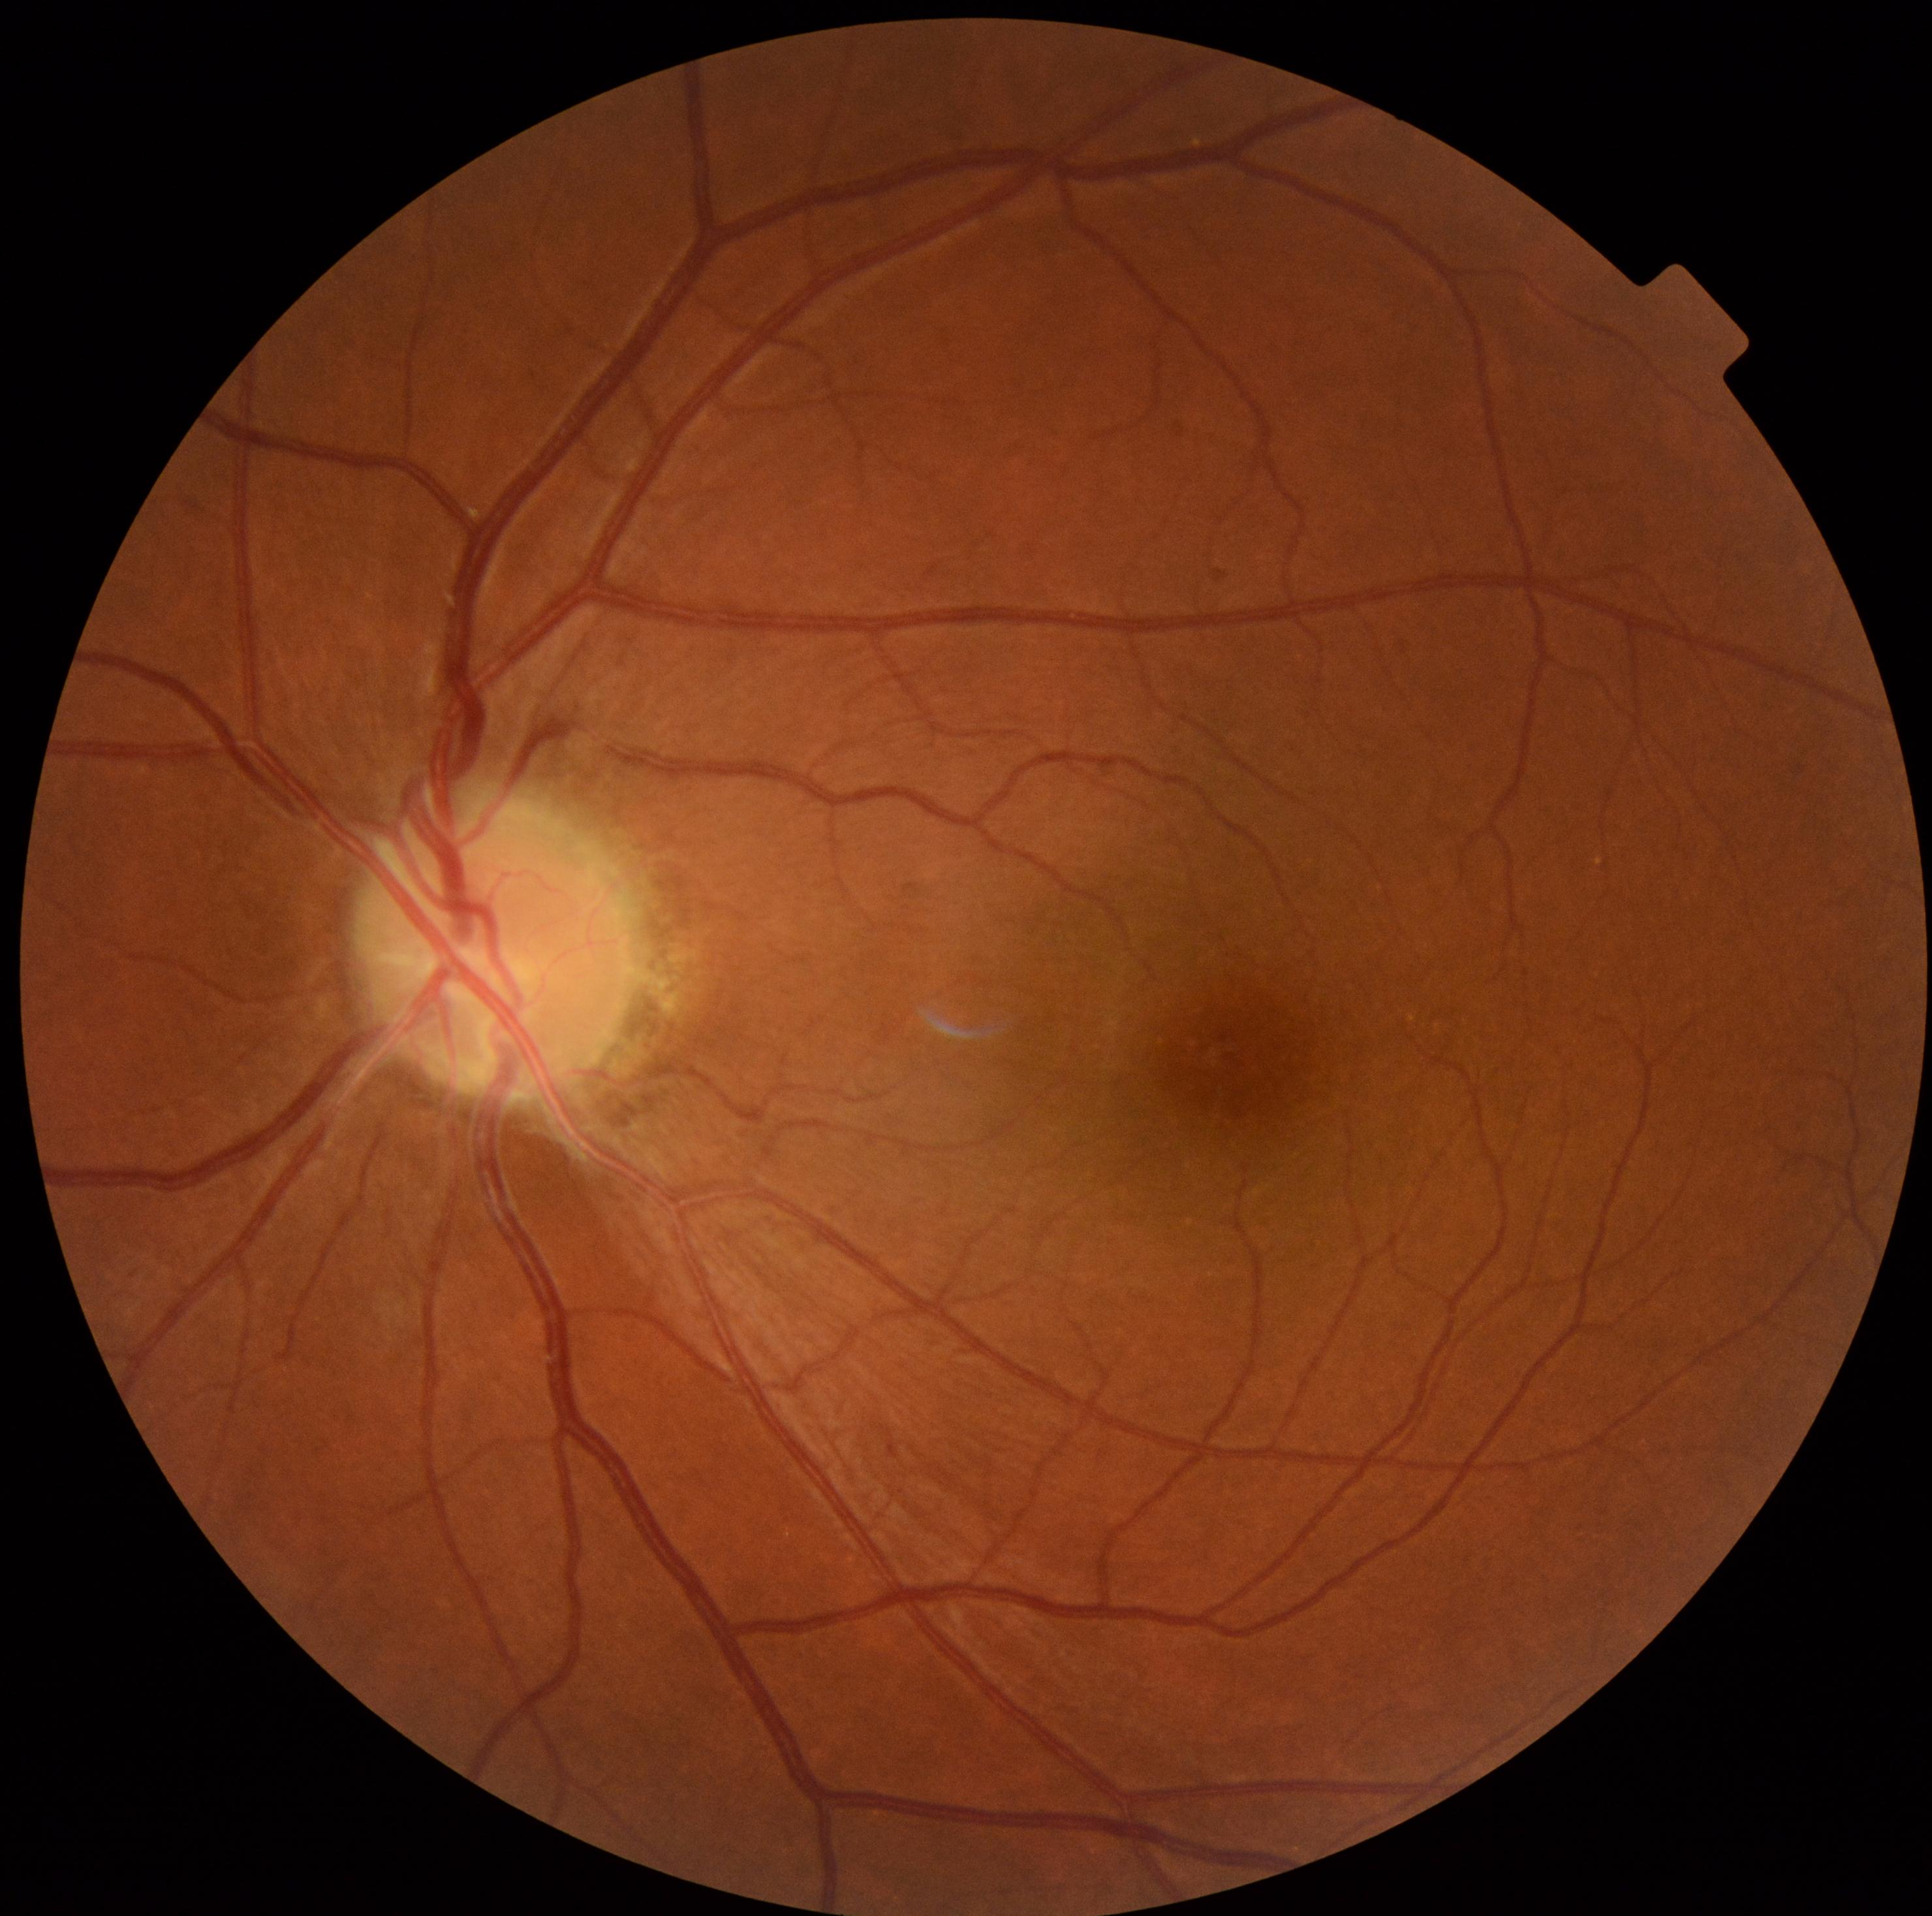

DR grade: 0.